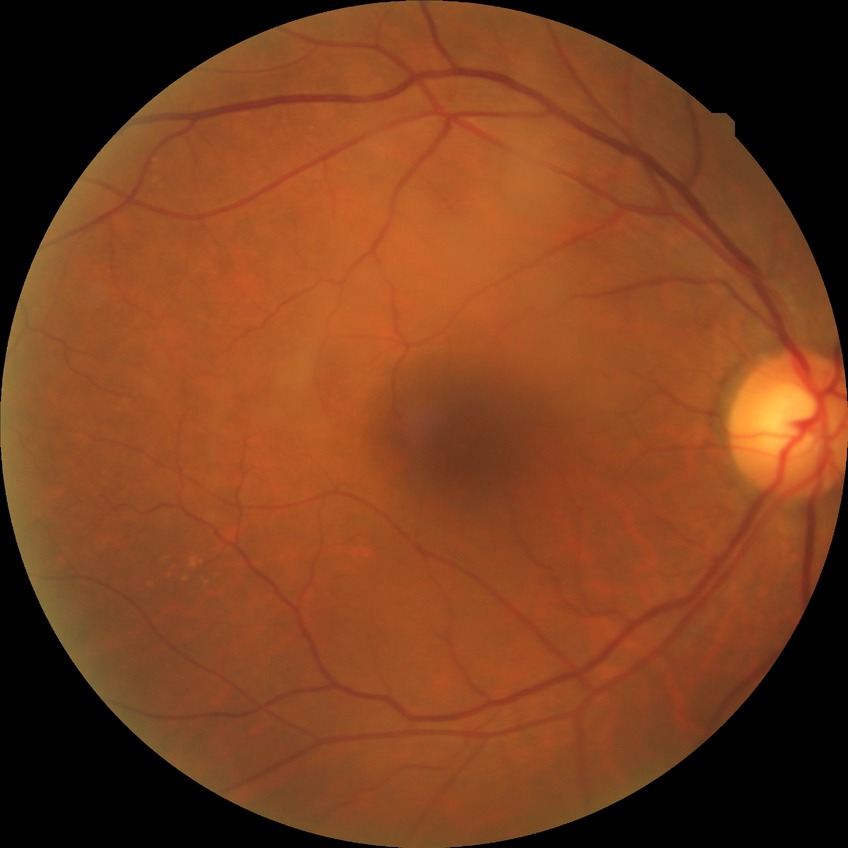
Diabetic retinopathy stage is no diabetic retinopathy.